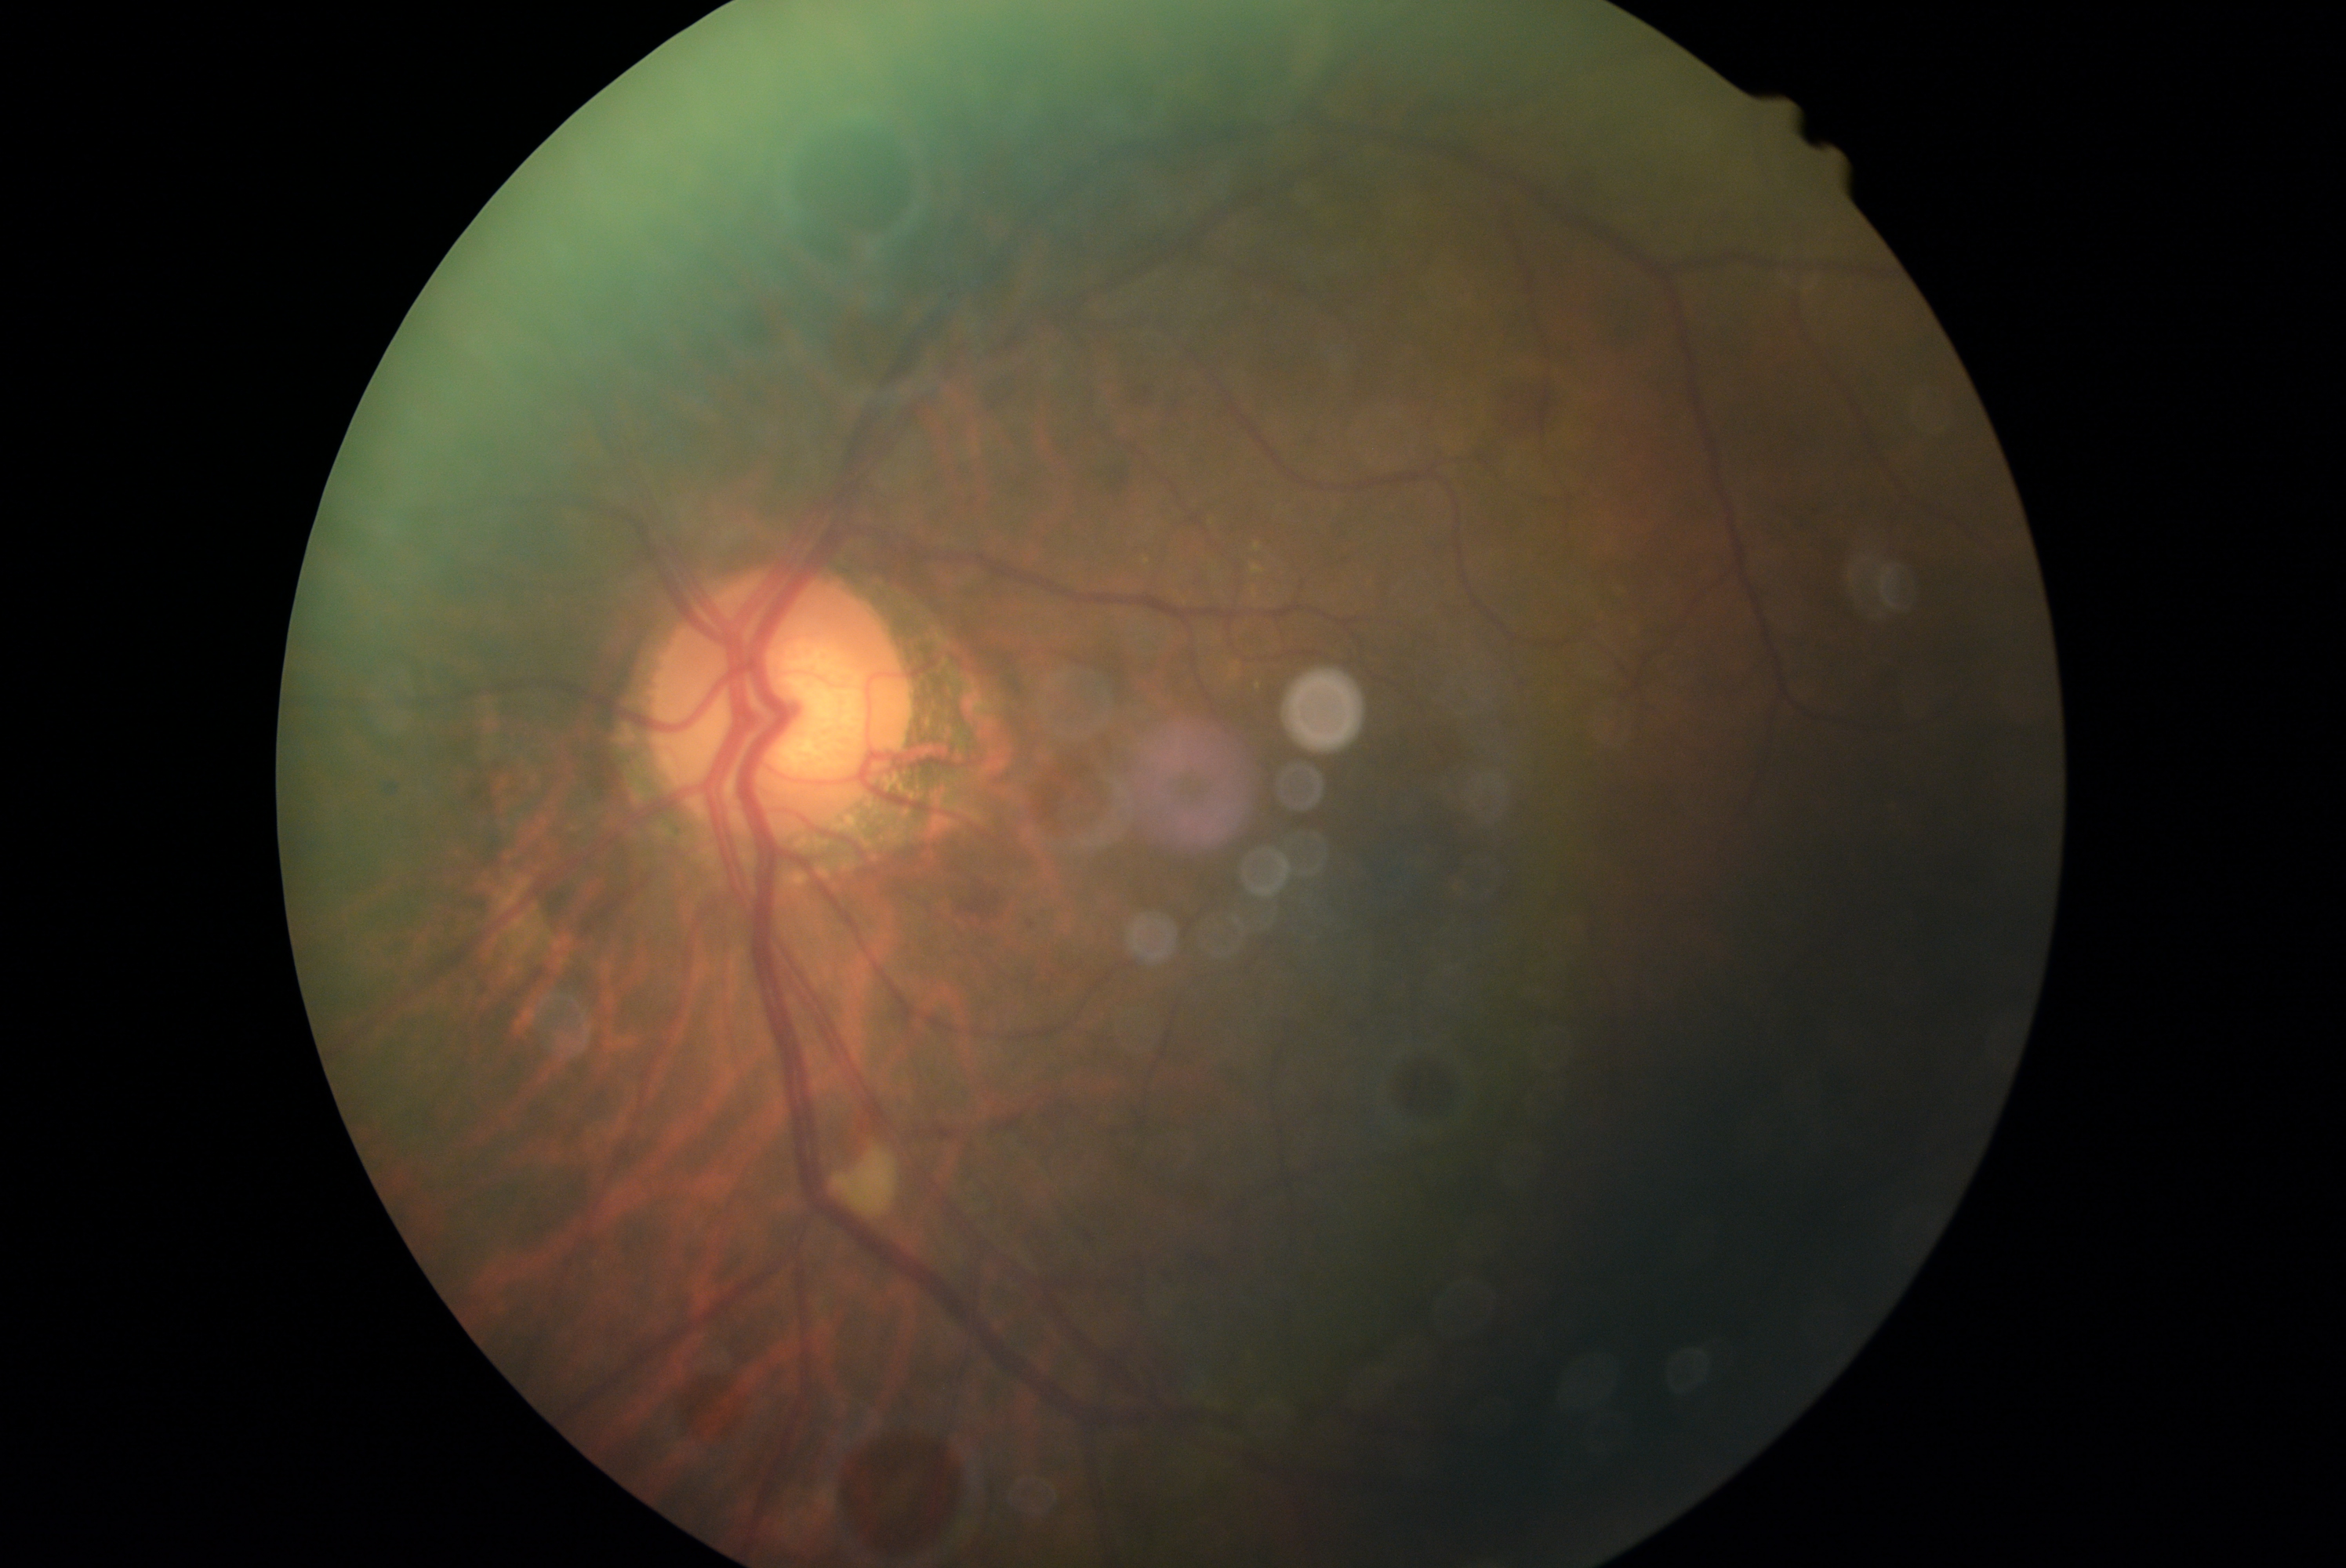 DR class: non-proliferative diabetic retinopathy. Diabetic retinopathy (DR): grade 2 (moderate NPDR).